2212x1659; color fundus photograph; FOV: 45 degrees
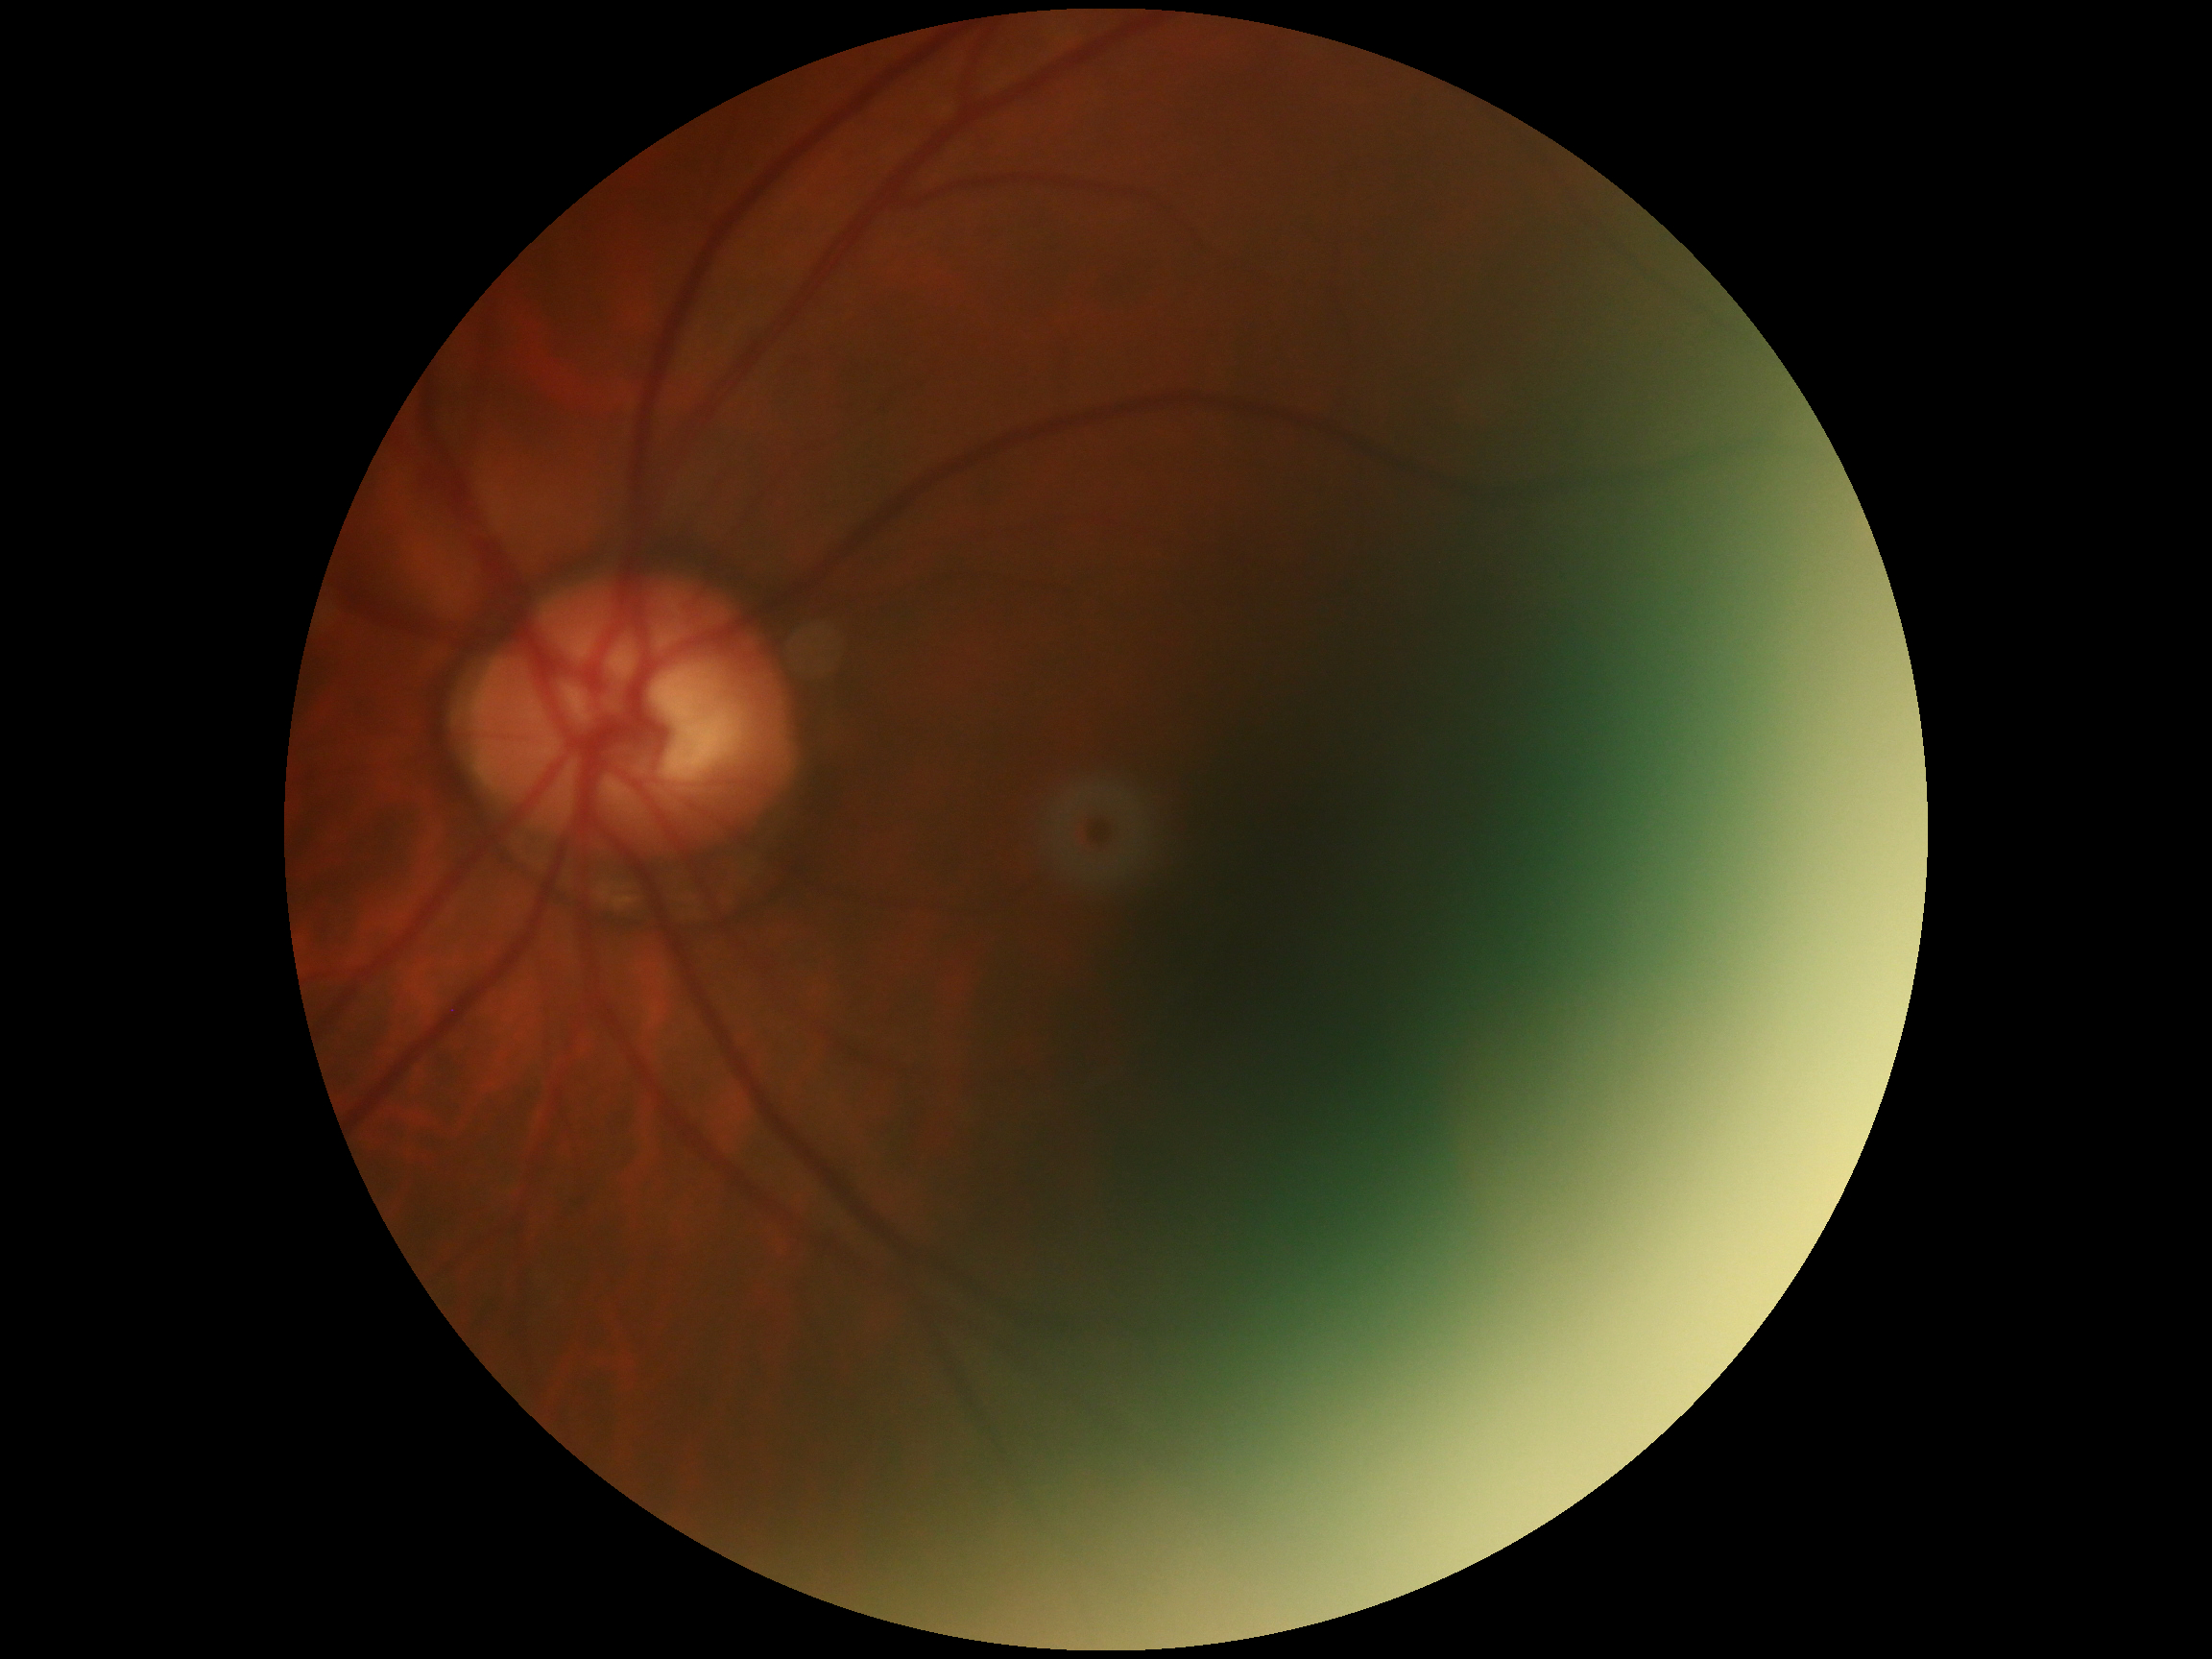
No signs of diabetic retinopathy. DR: no apparent diabetic retinopathy (grade 0).